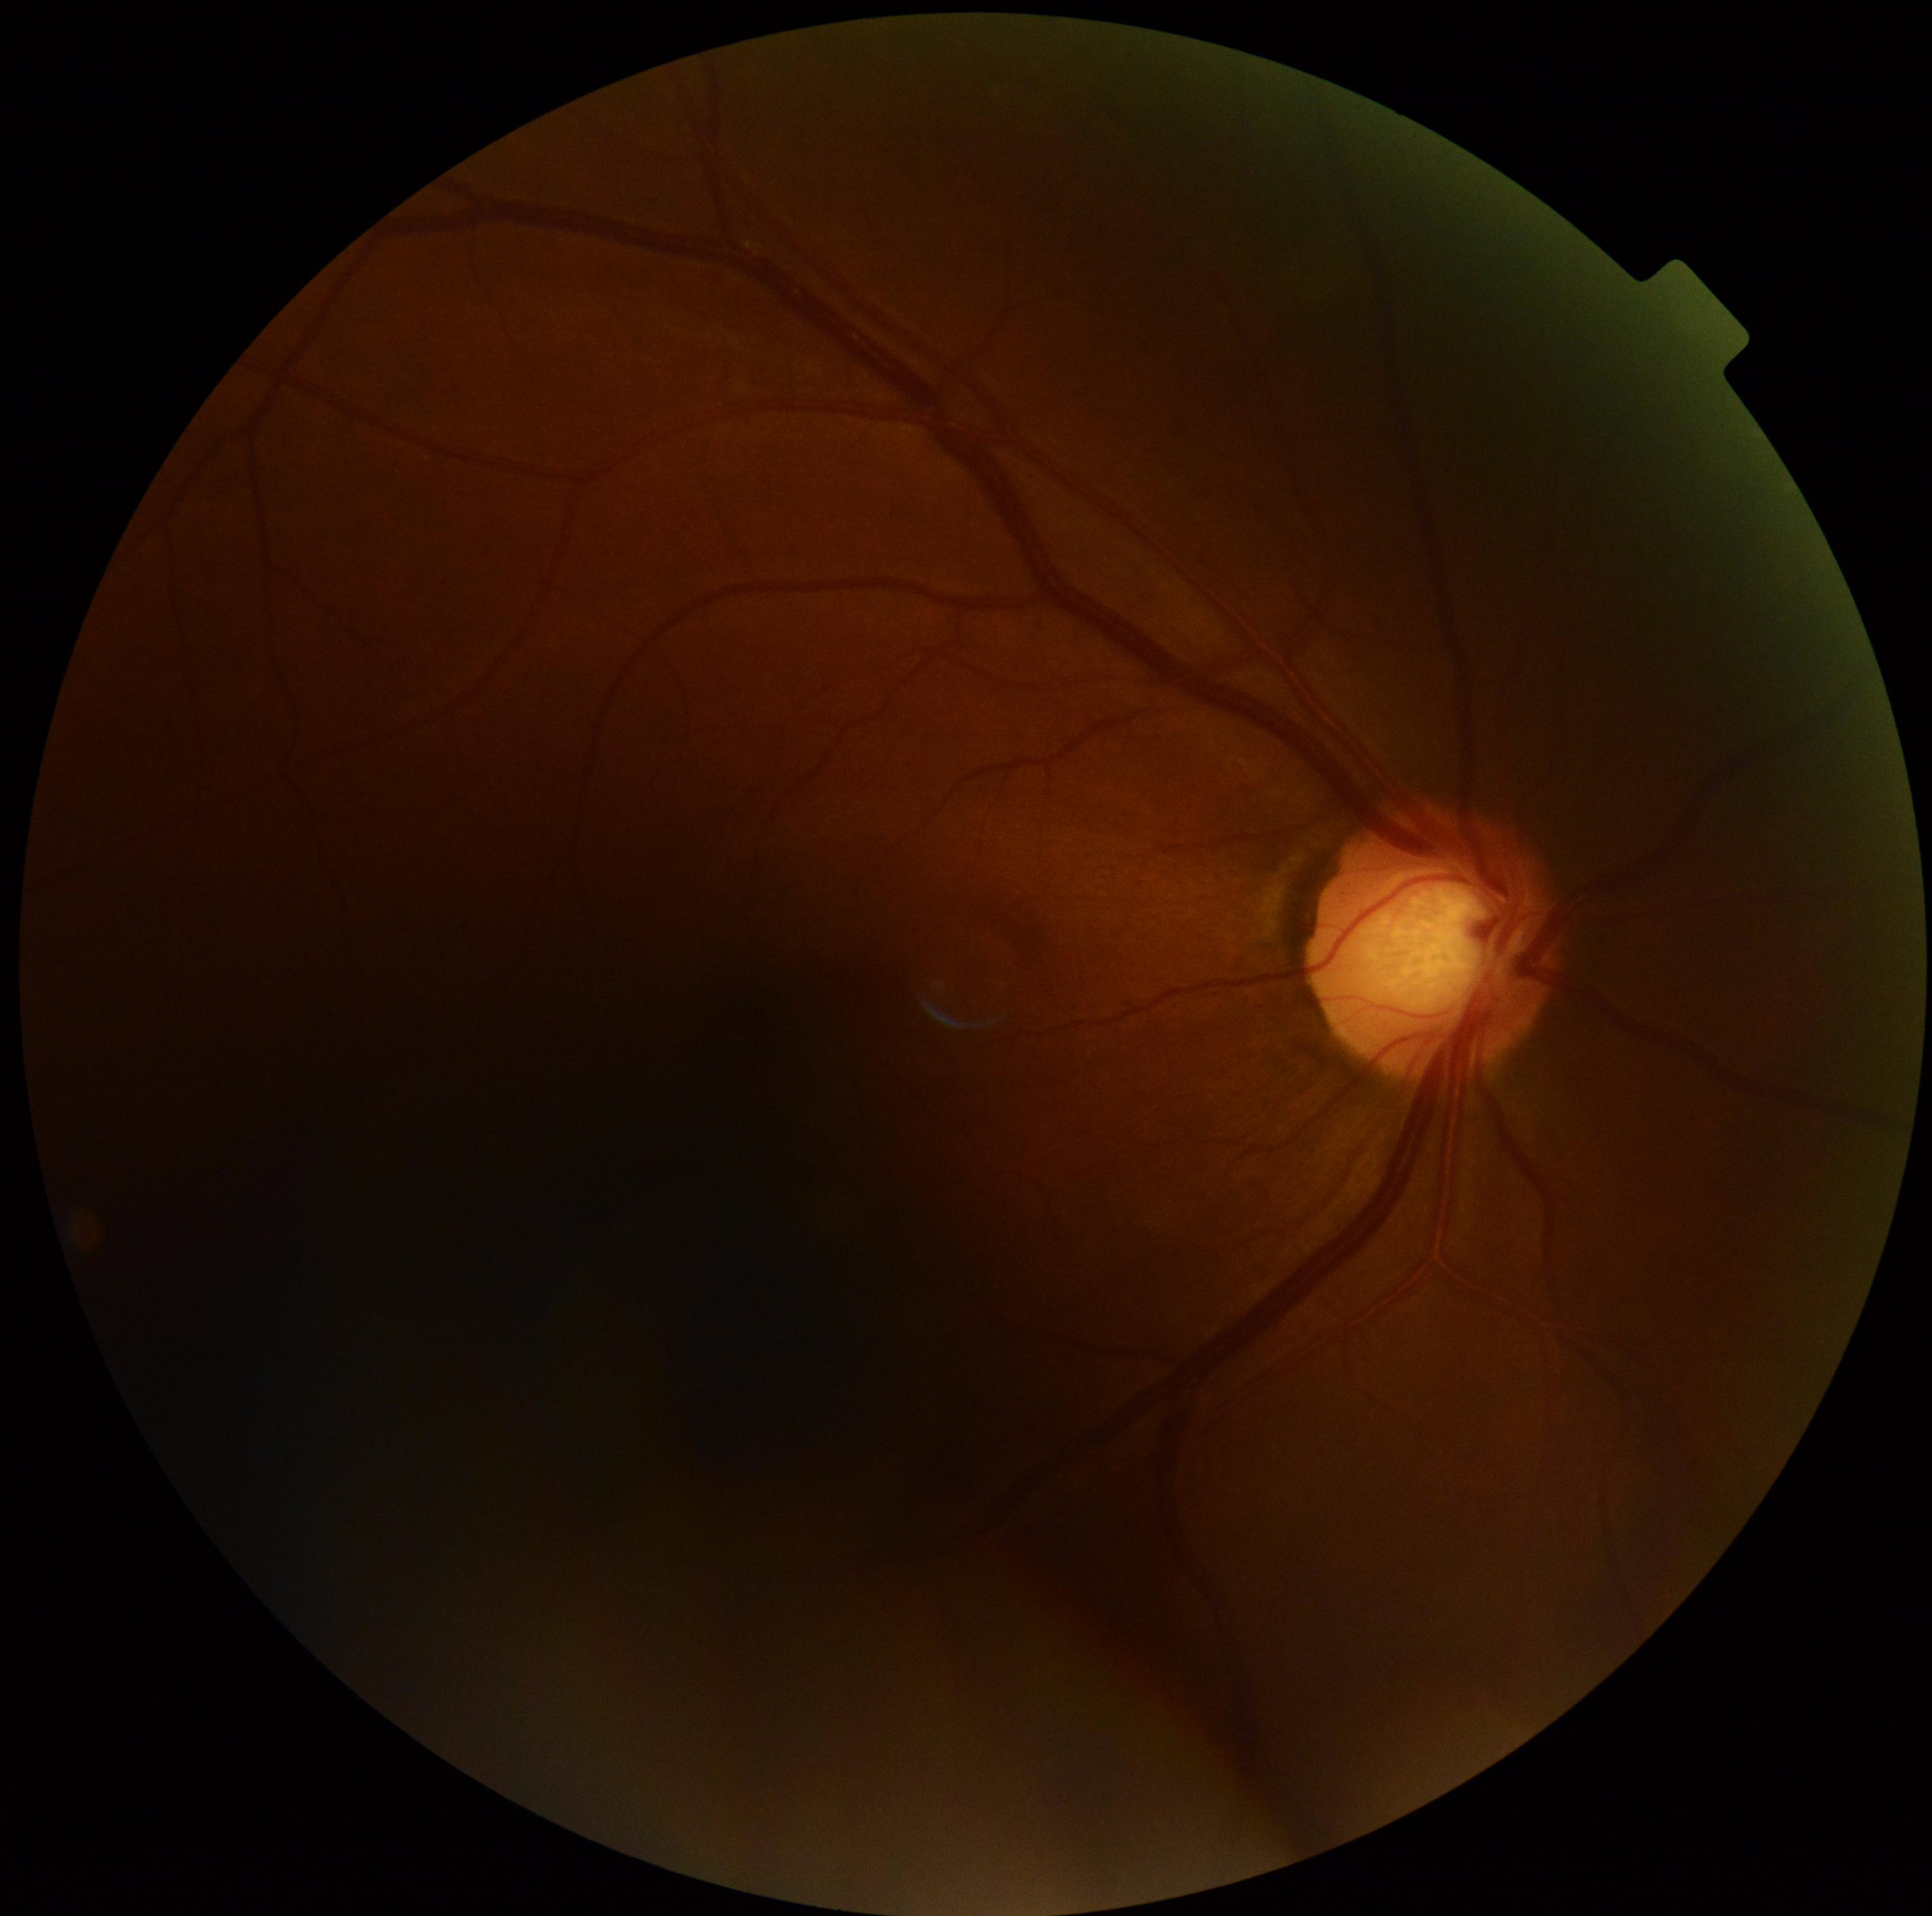 Diabetic retinopathy grade: 0 (no apparent retinopathy).